Wide-field fundus photograph from neonatal ROP screening. Natus RetCam Envision, 130° FOV. 1440x1080px:
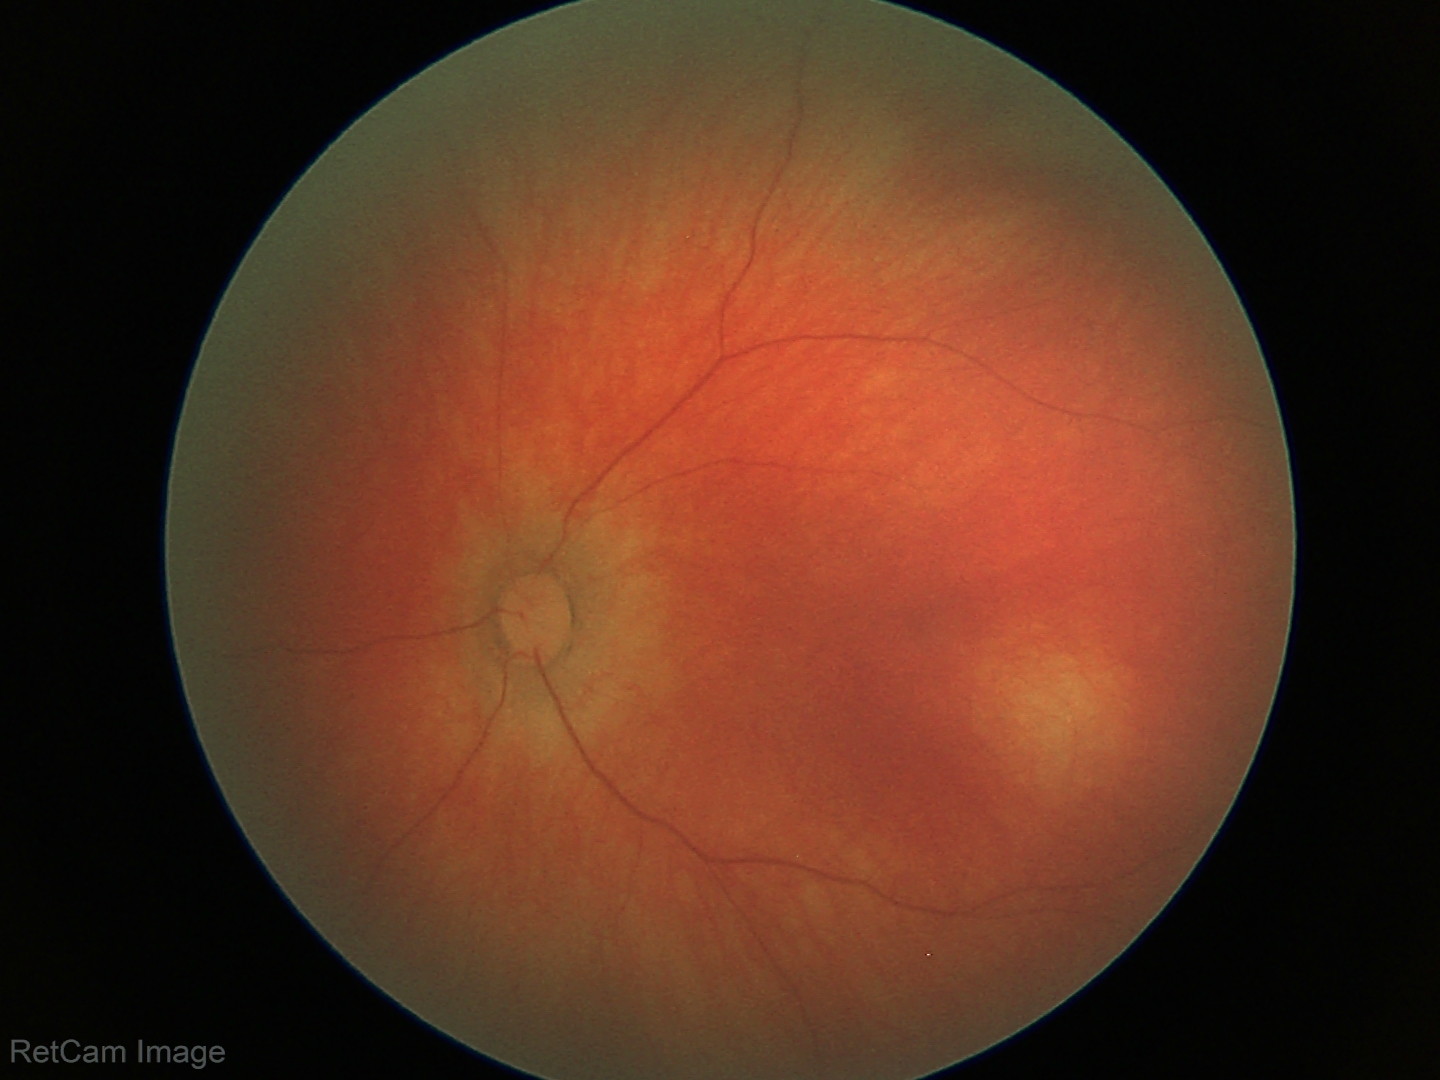
Q: What is the diagnosis from this examination?
A: physiological retinal finding